2352 by 1568 pixels. 45° FOV
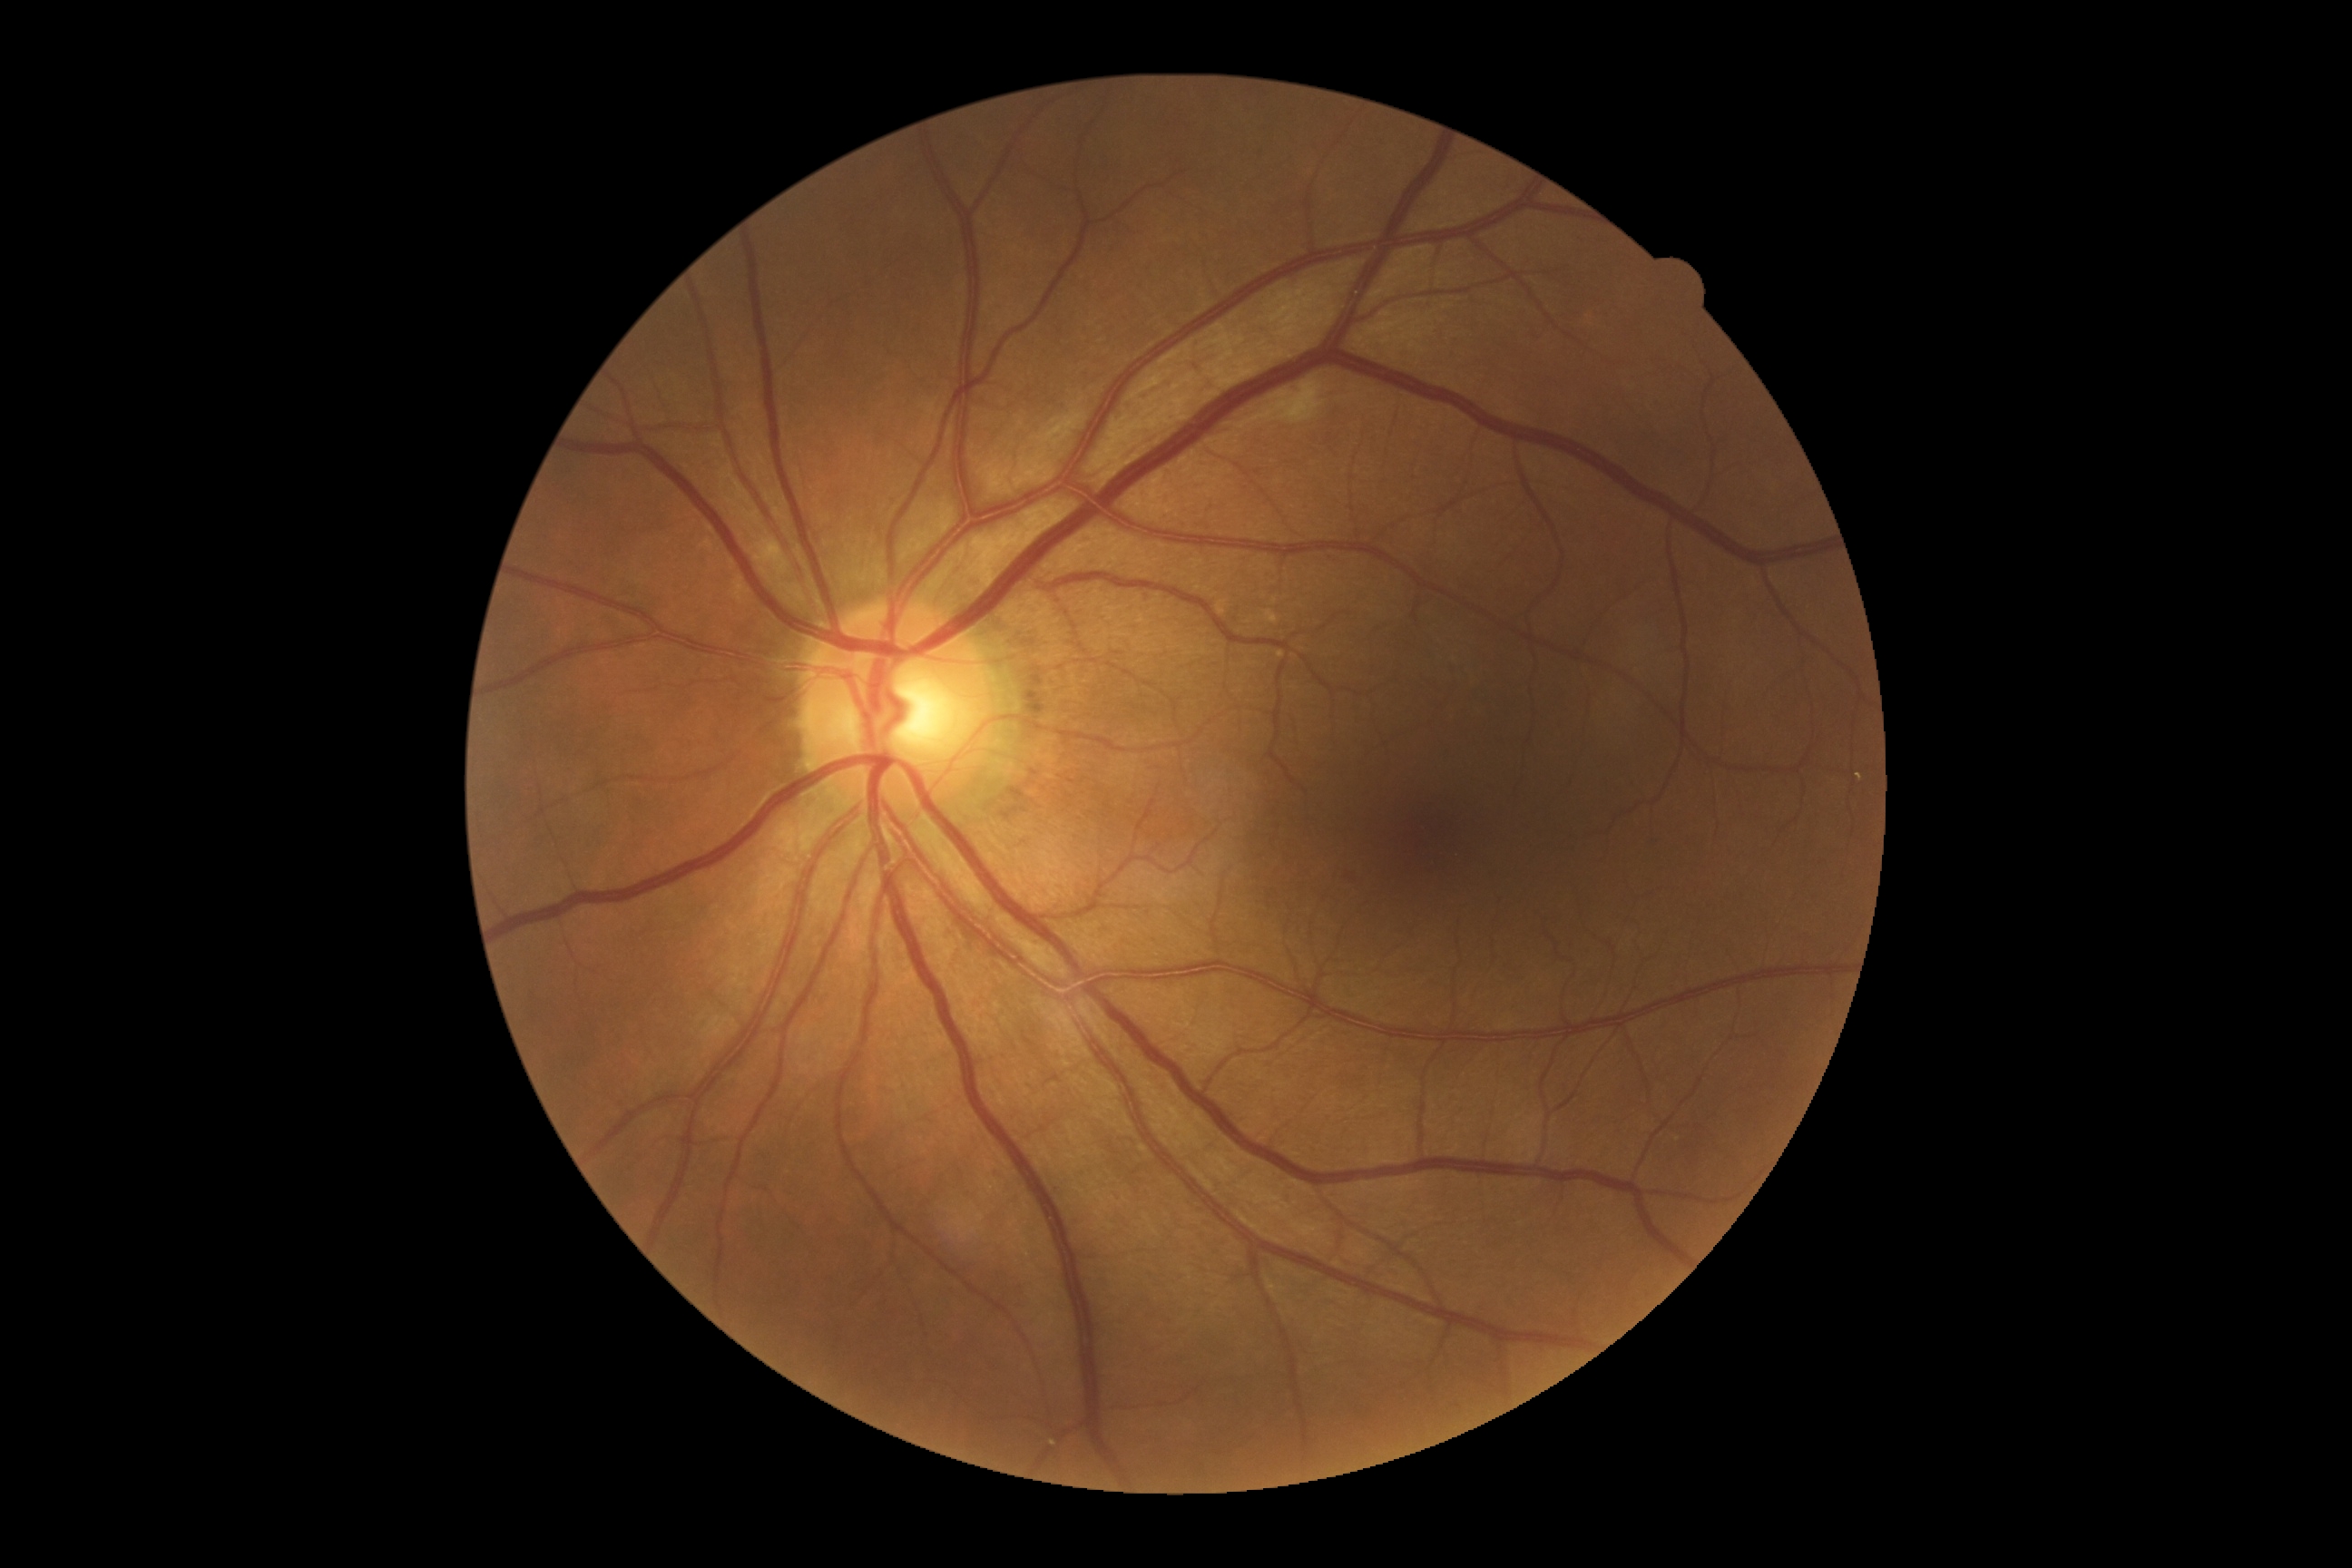 Annotations:
– DR grade — 2 (moderate NPDR)
– DR class — non-proliferative diabetic retinopathy